Infant wide-field fundus photograph; 1440 by 1080 pixels — 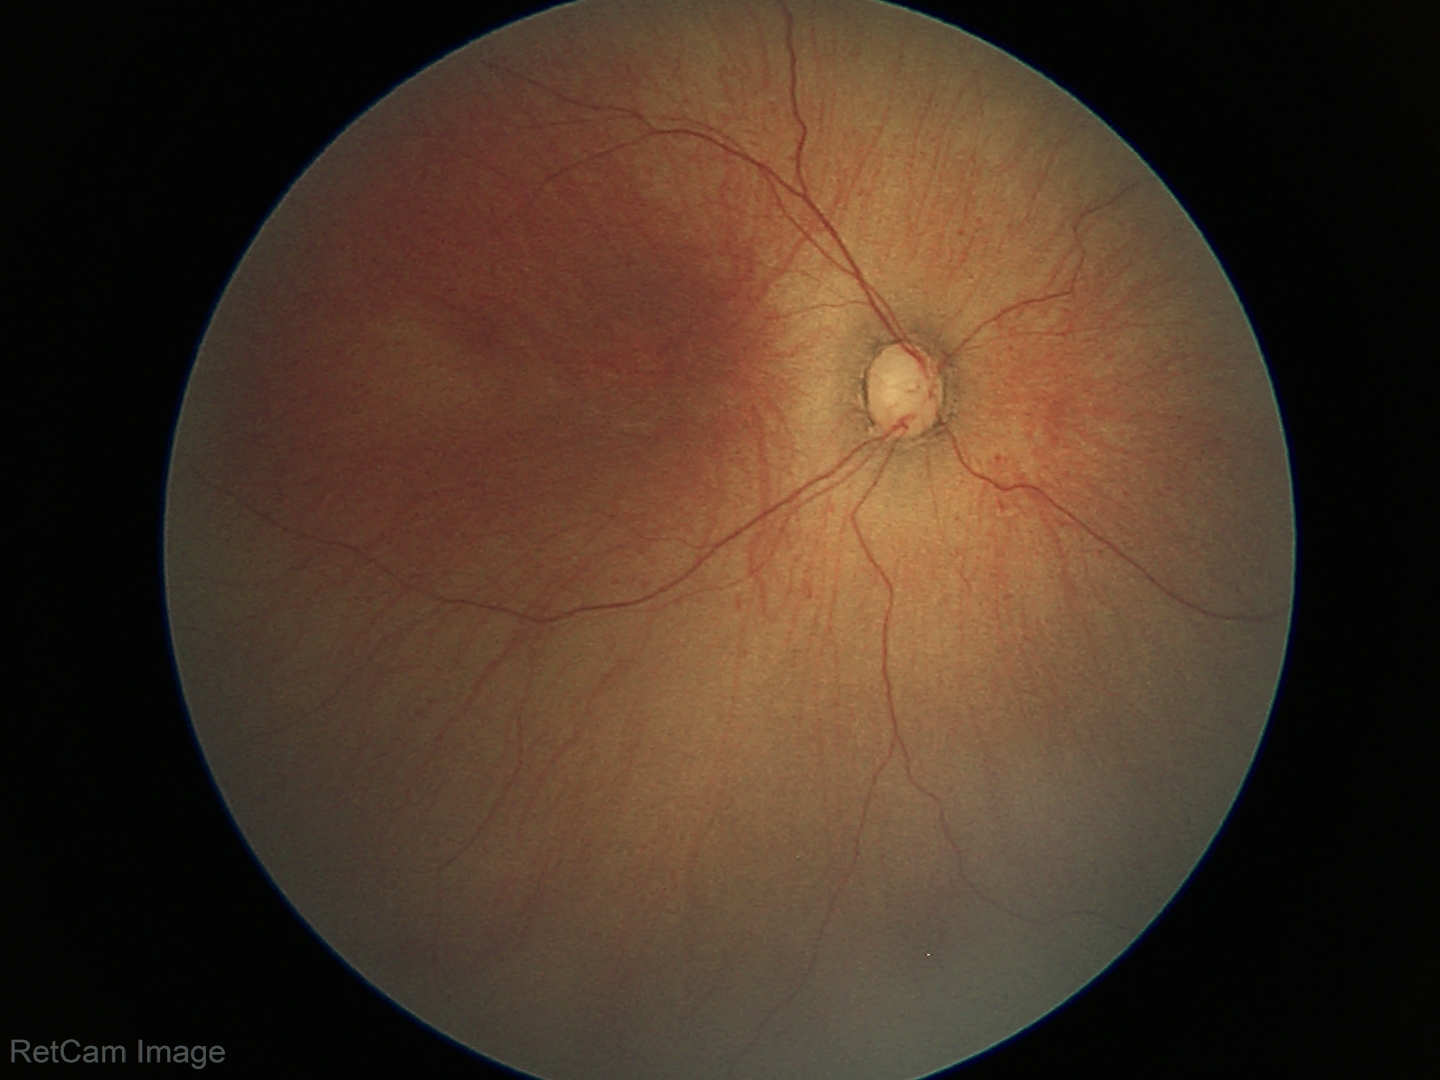

Diagnosis from this screening exam: ROP stage 1.
Without plus disease.